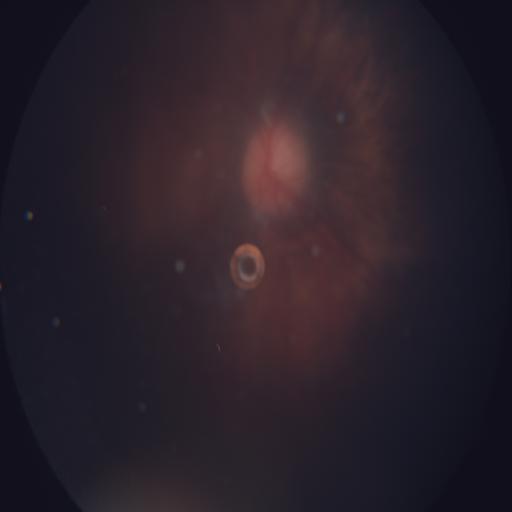
There is evidence of optic disc edema.